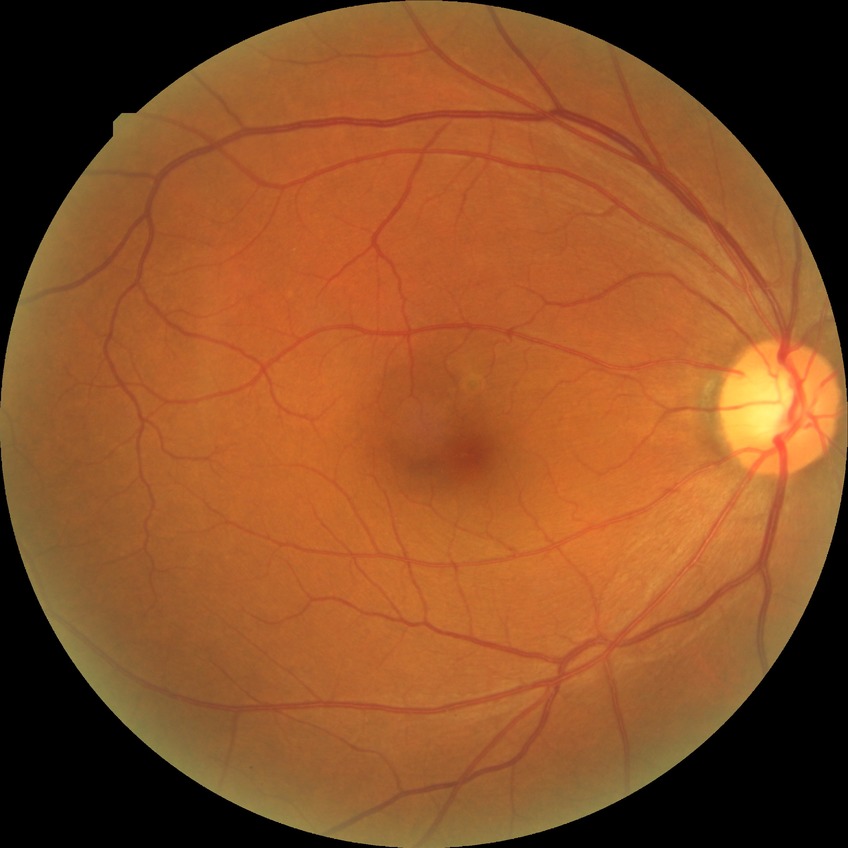
Diabetic retinopathy (DR): NDR (no diabetic retinopathy).